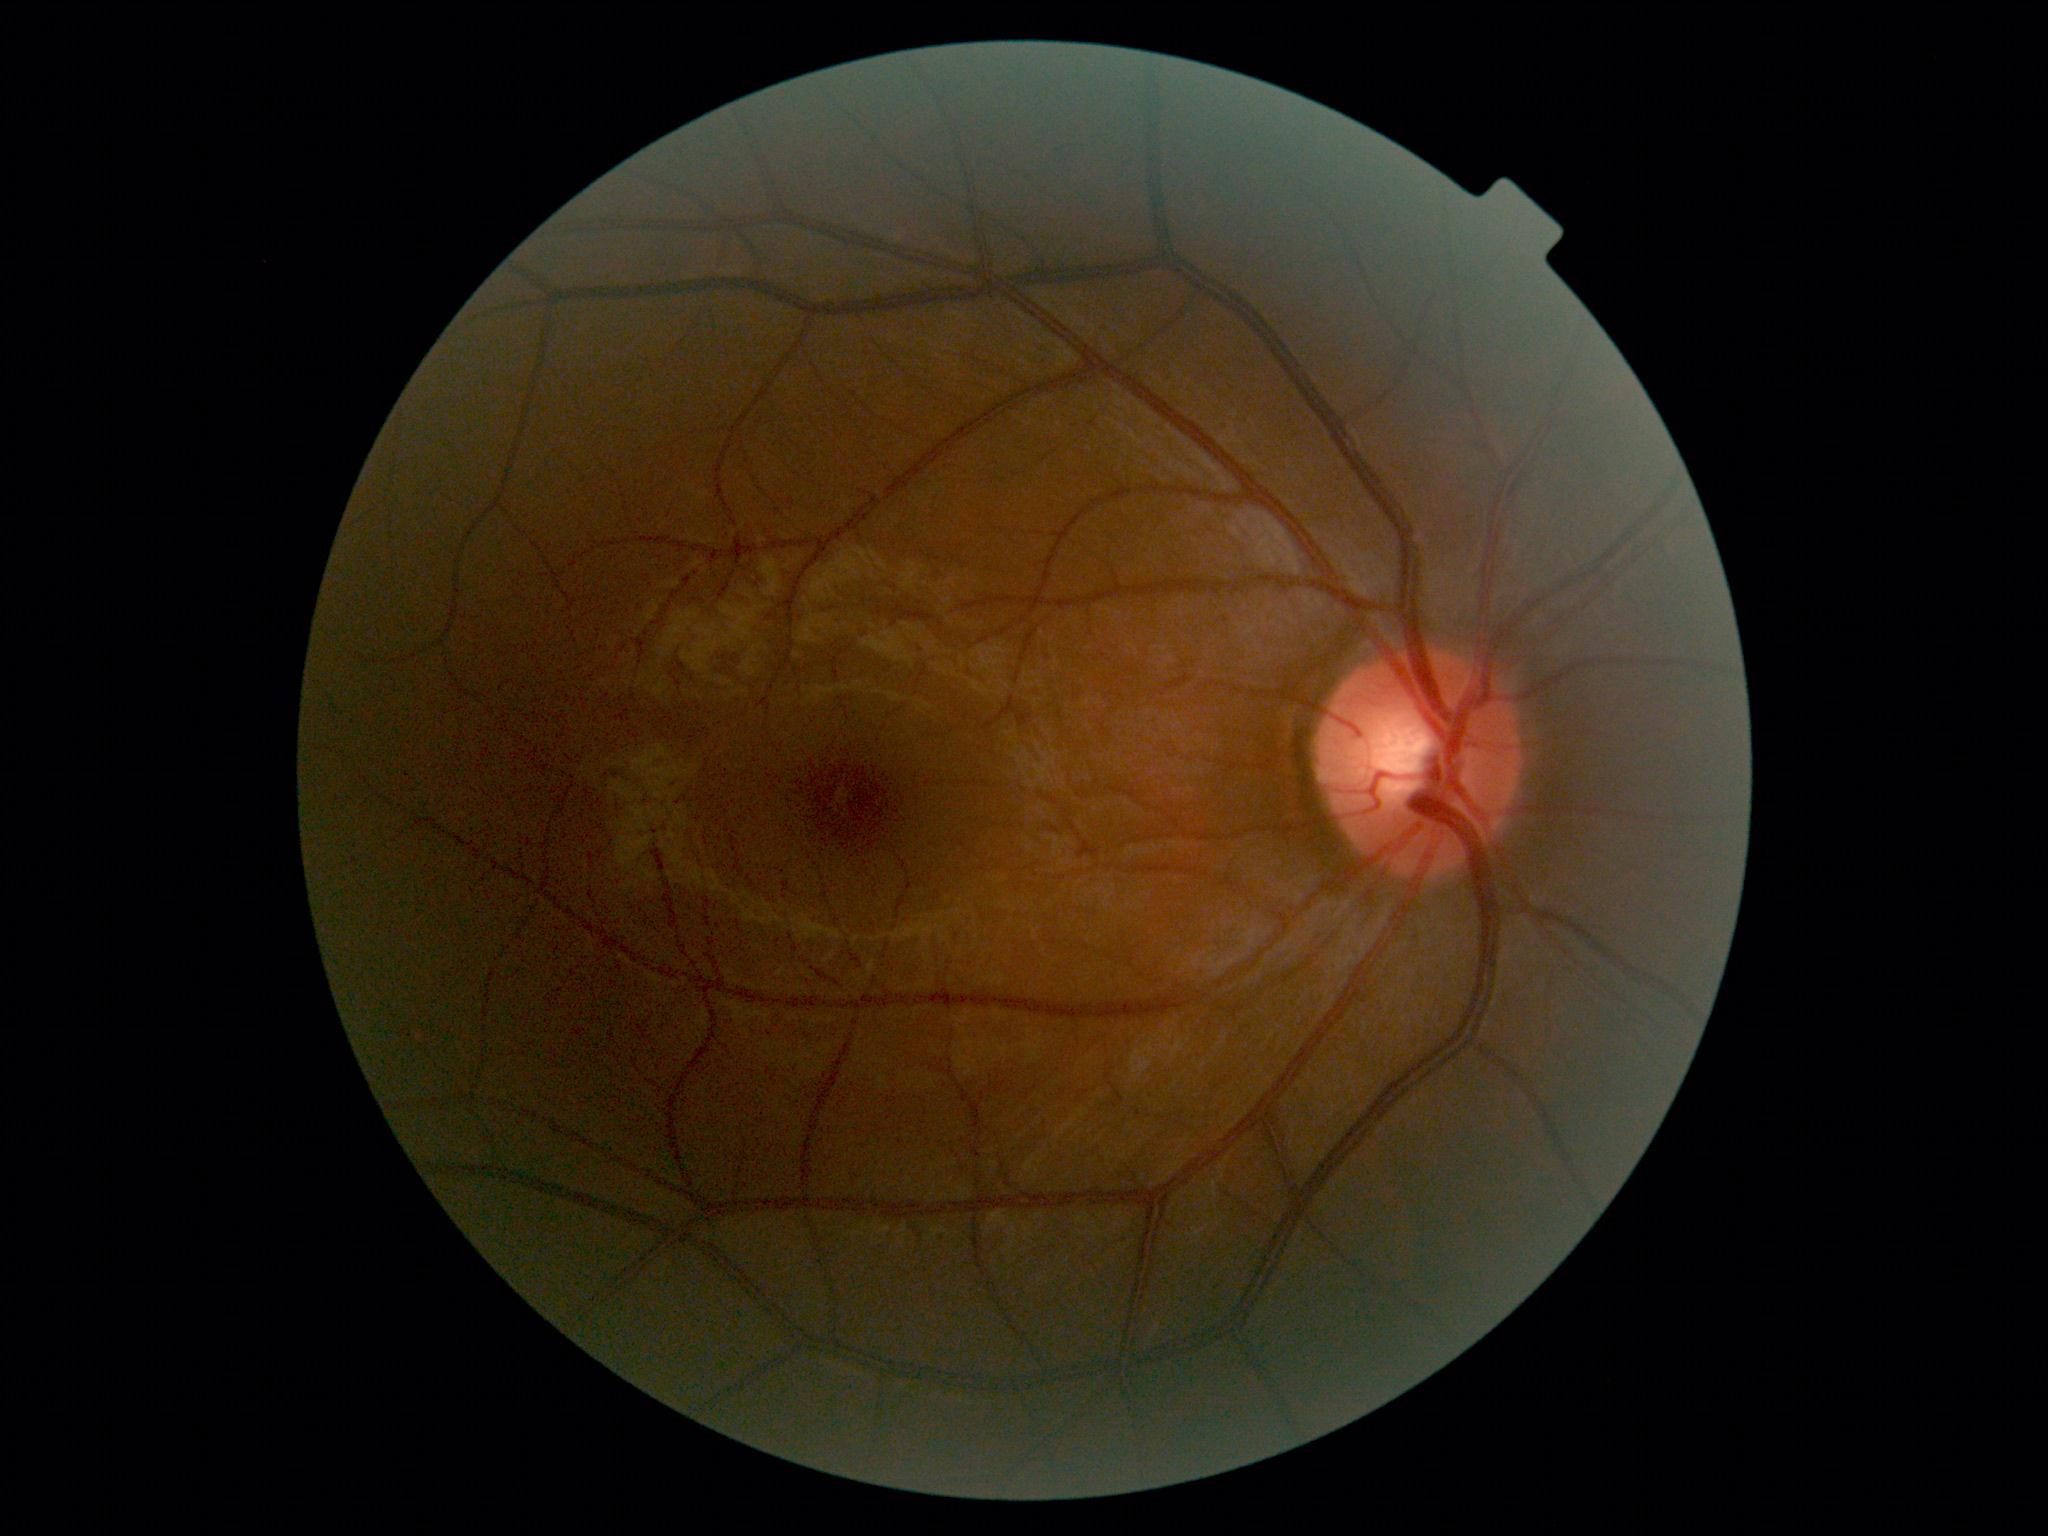 Diabetic retinopathy: no apparent diabetic retinopathy (grade 0).
No signs of diabetic retinopathy.